Captured with pupil dilation · disc-centered fundus crop: 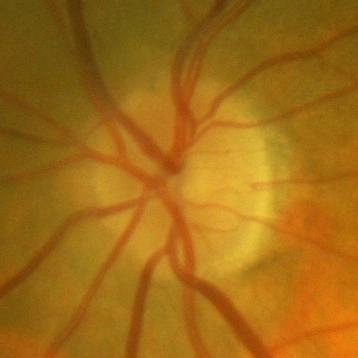

No glaucomatous findings.